Optic nerve head photograph.
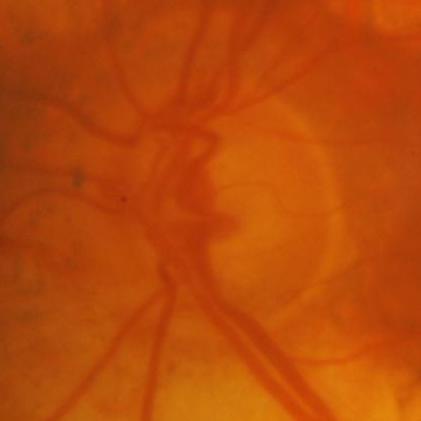 Glaucomatous changes are present. Impression: glaucomatous findings.